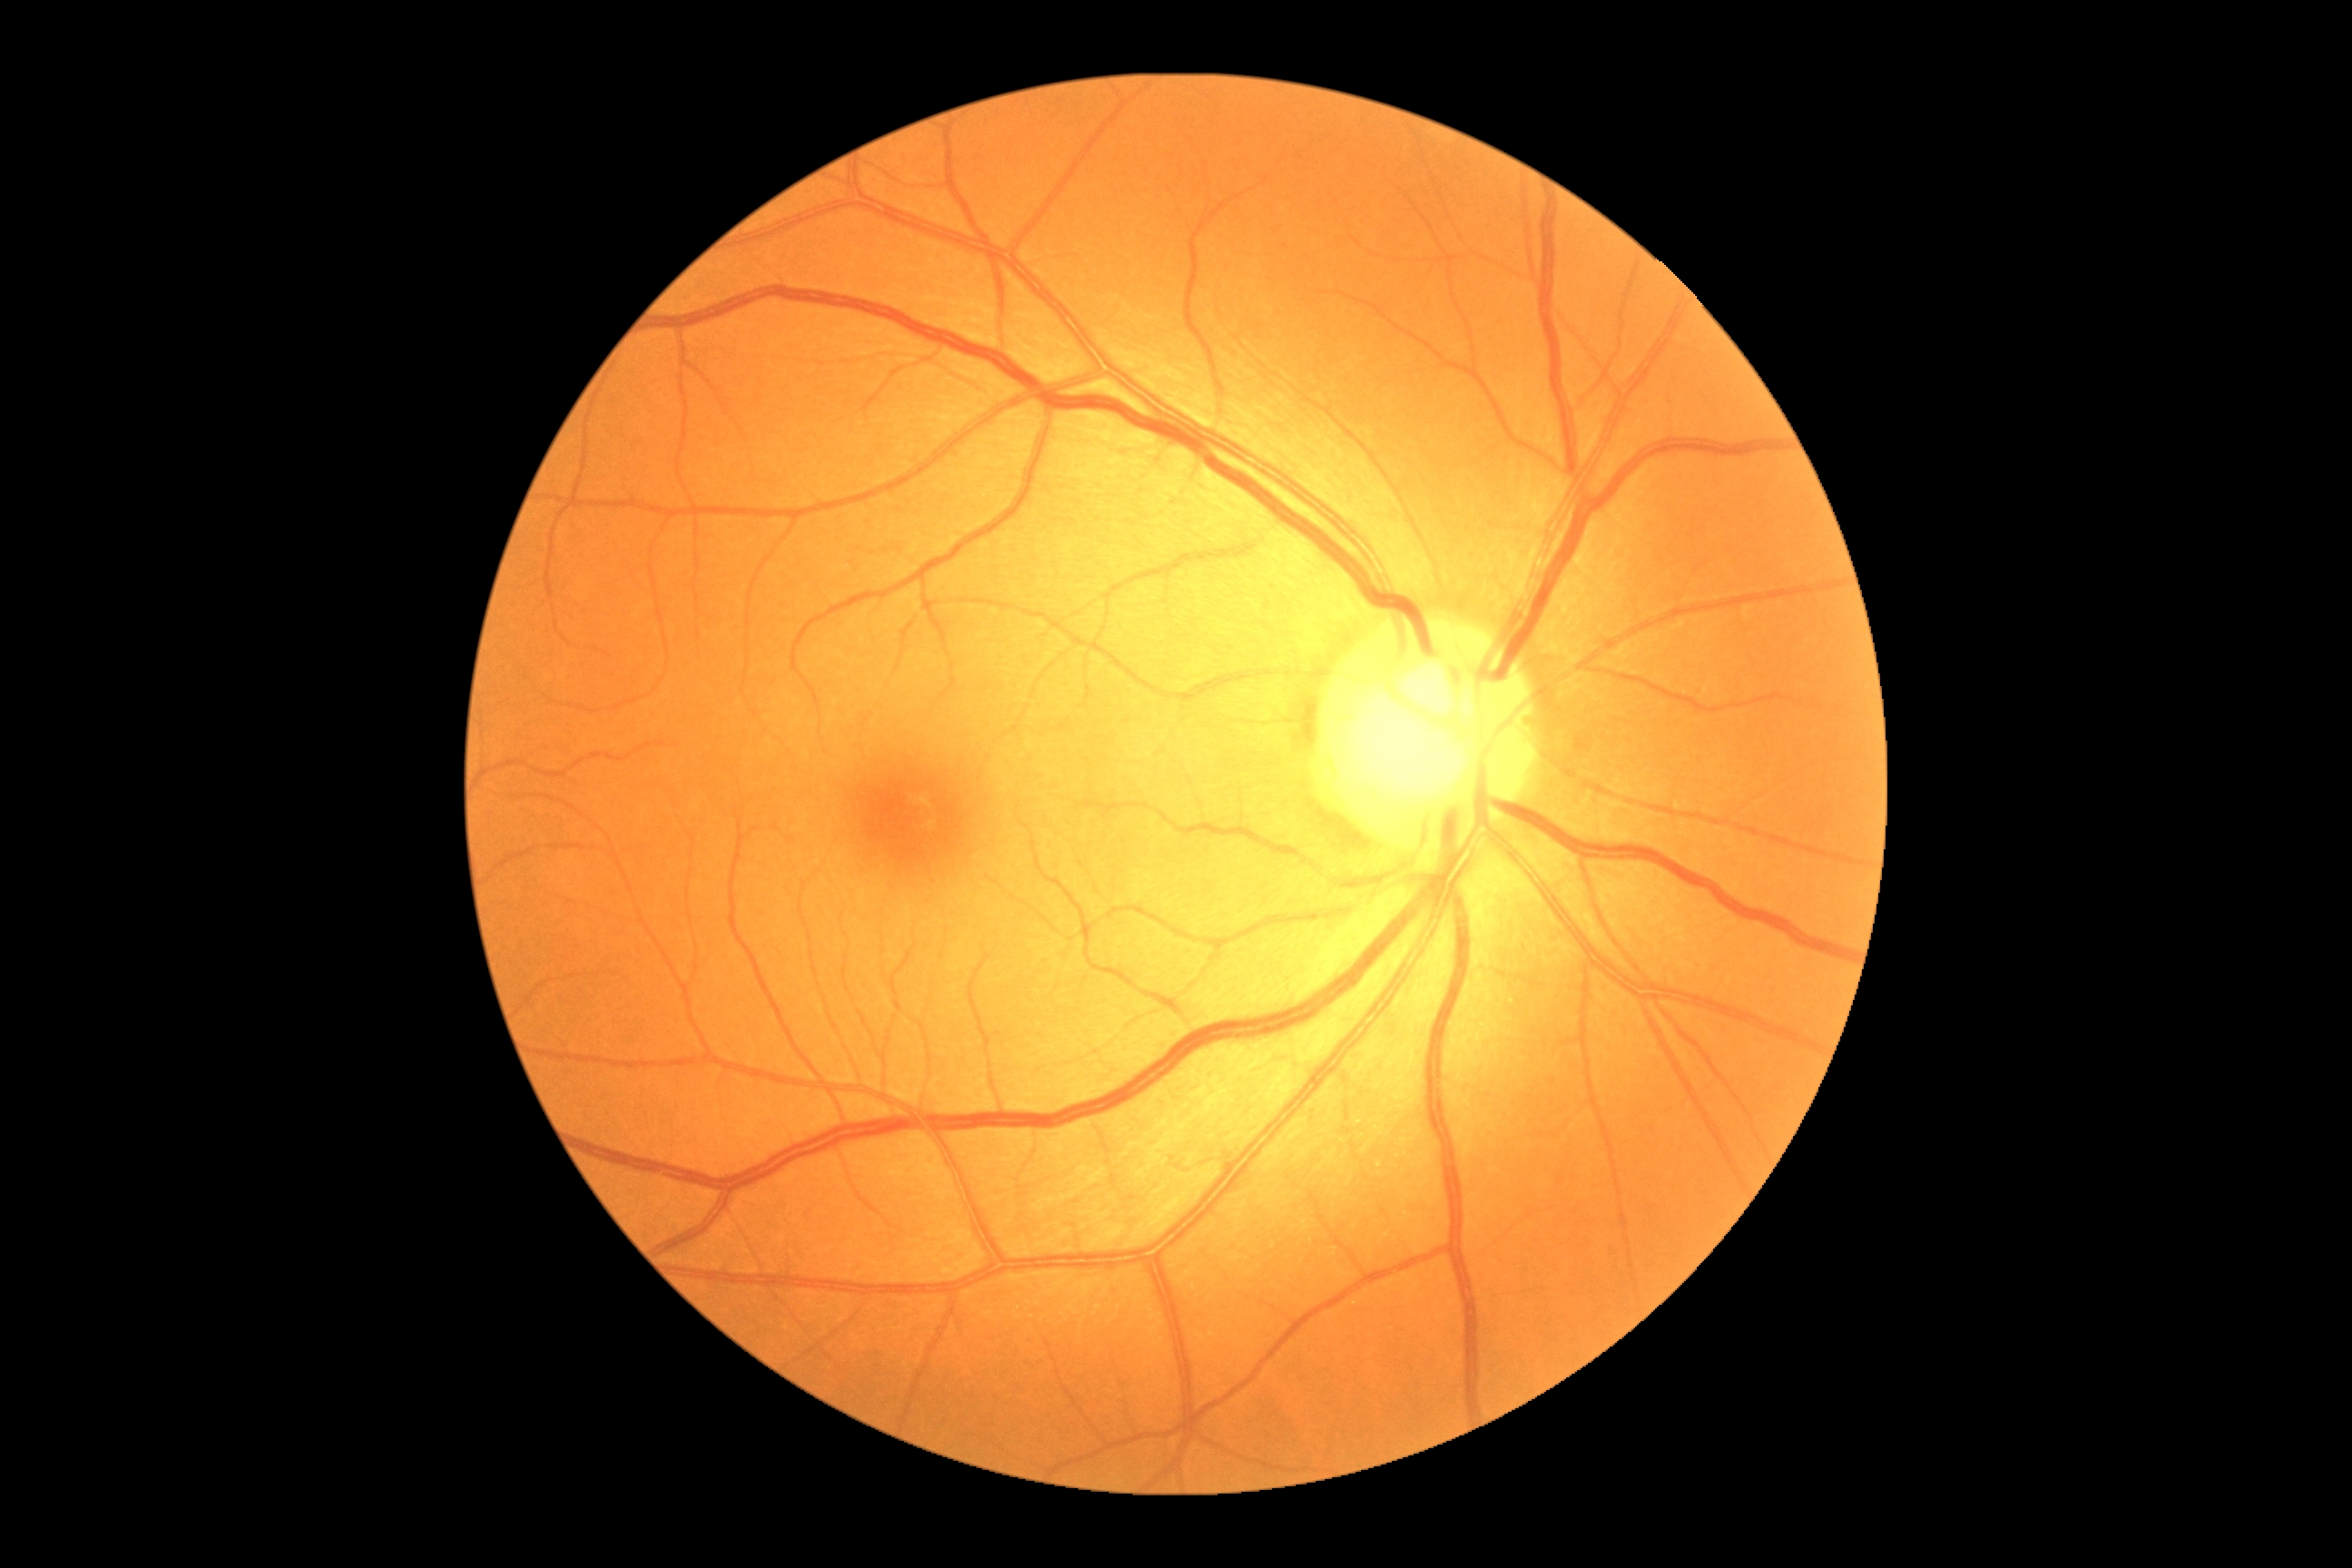   dr_grade: 0/4